Color fundus photograph. Acquired with a NIDEK AFC-230 — 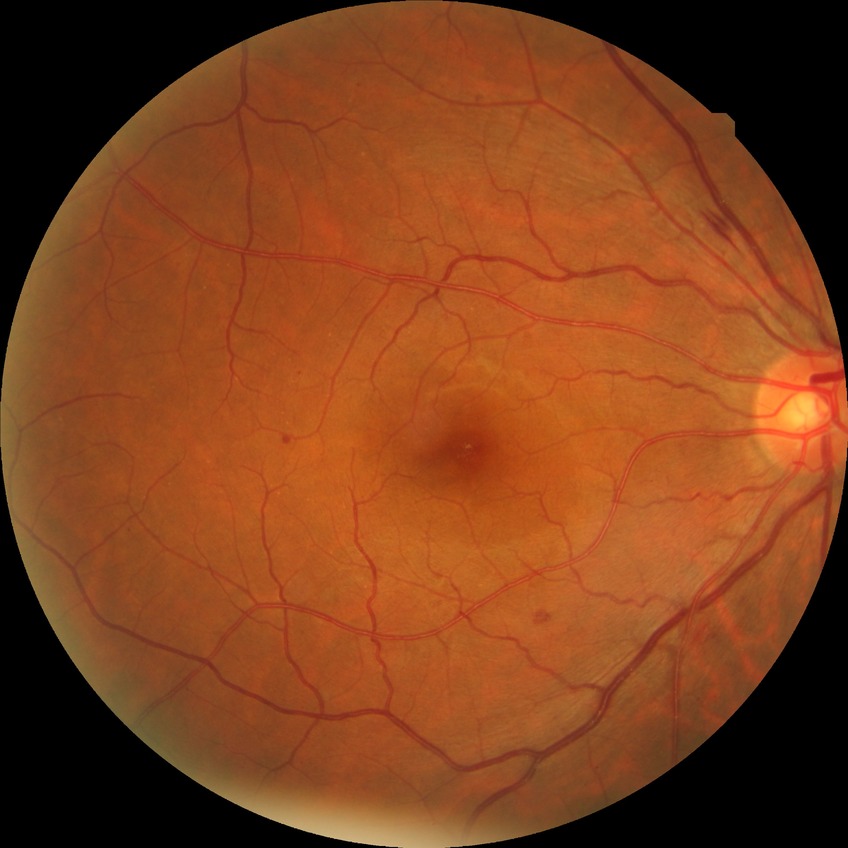 The retinopathy is classified as non-proliferative diabetic retinopathy. Davis stage: SDR.